Wide-field fundus photograph of an infant:
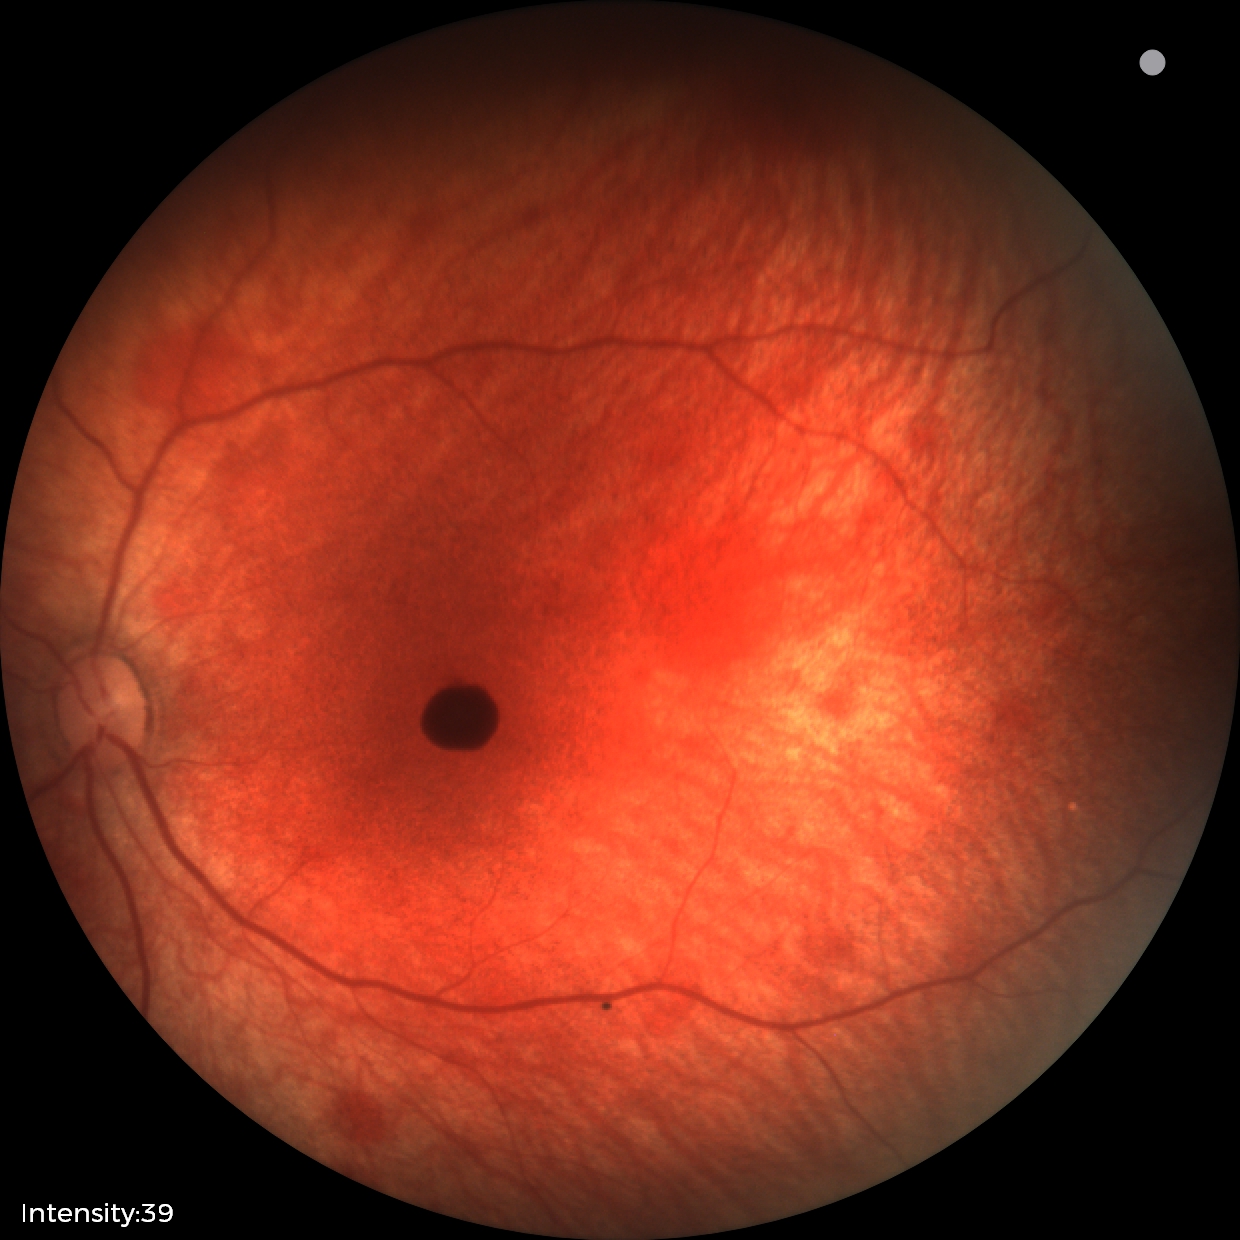 Series diagnosed as retinal hemorrhages.